Modified Davis classification: 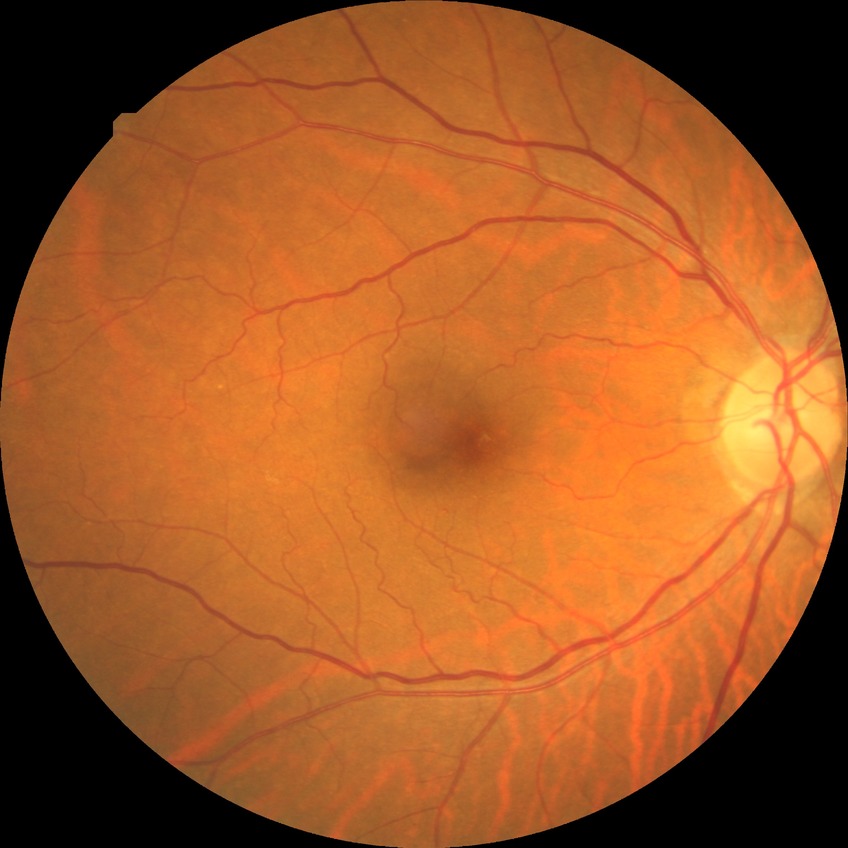 DR stage=NDR.